45° field of view.
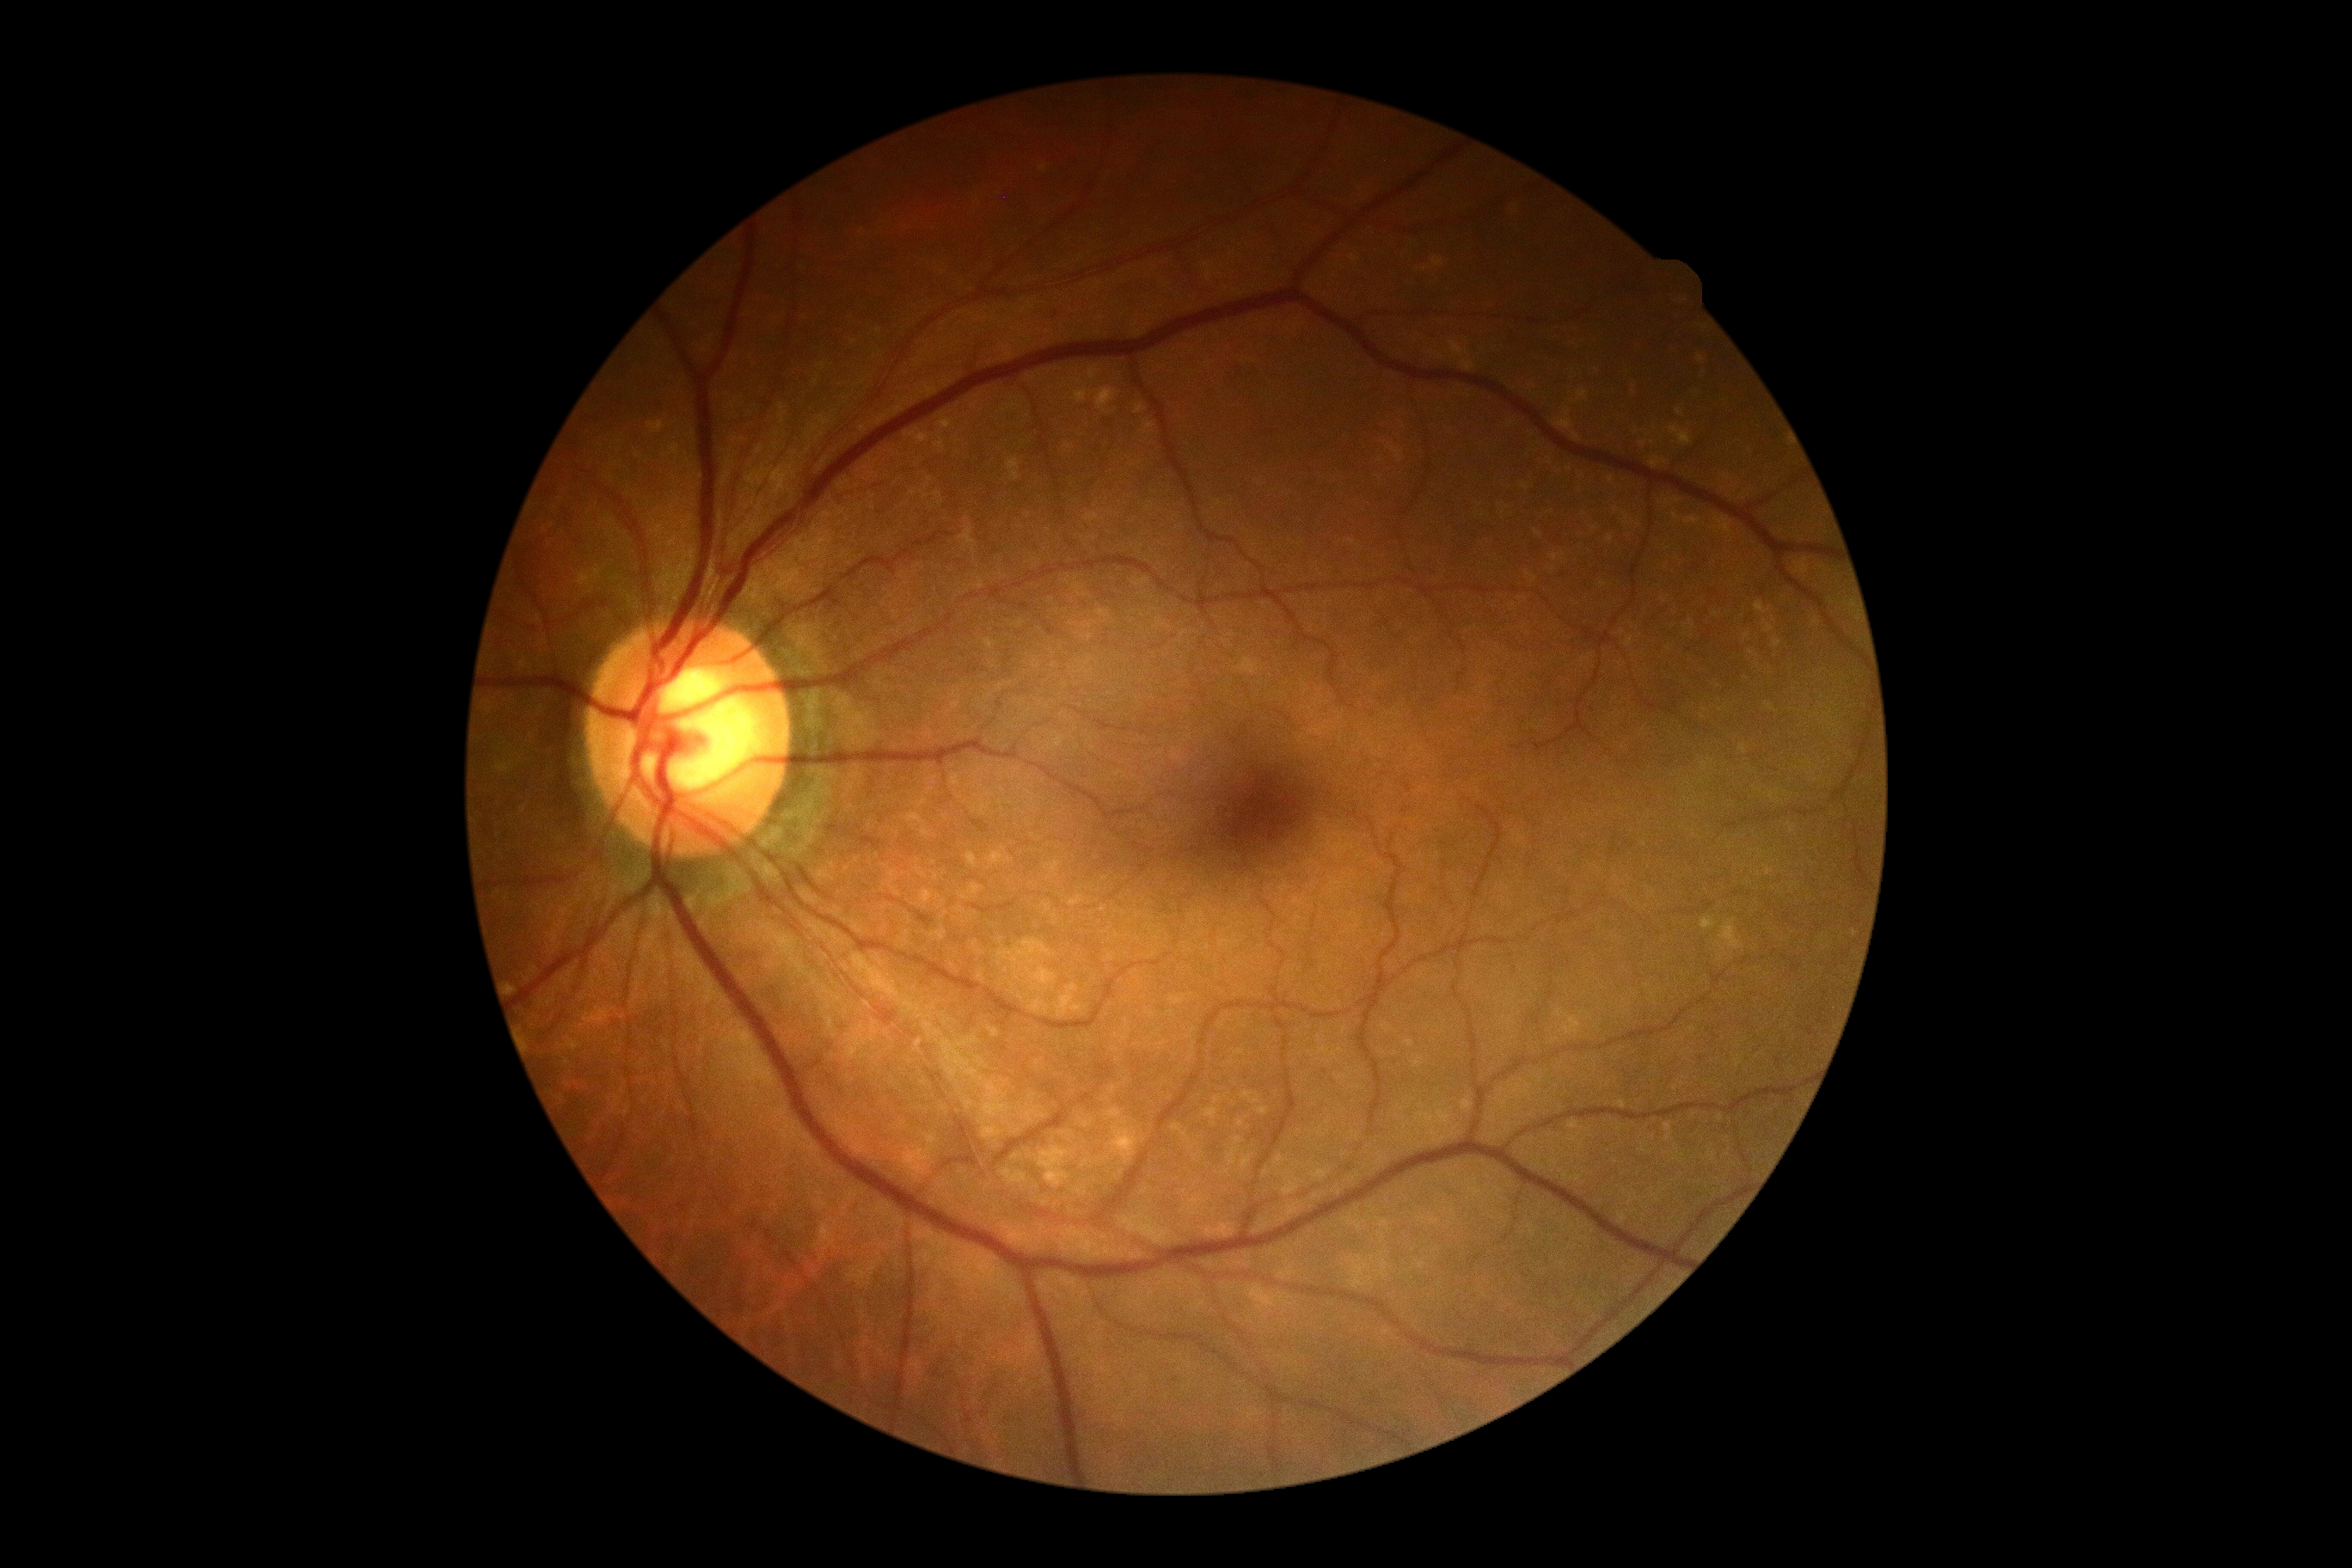 {
  "dr_grade": "grade 0",
  "dr_impression": "negative for DR"
}